Retinal fundus photograph. 848 x 848 pixels. Nonmydriatic fundus photograph: 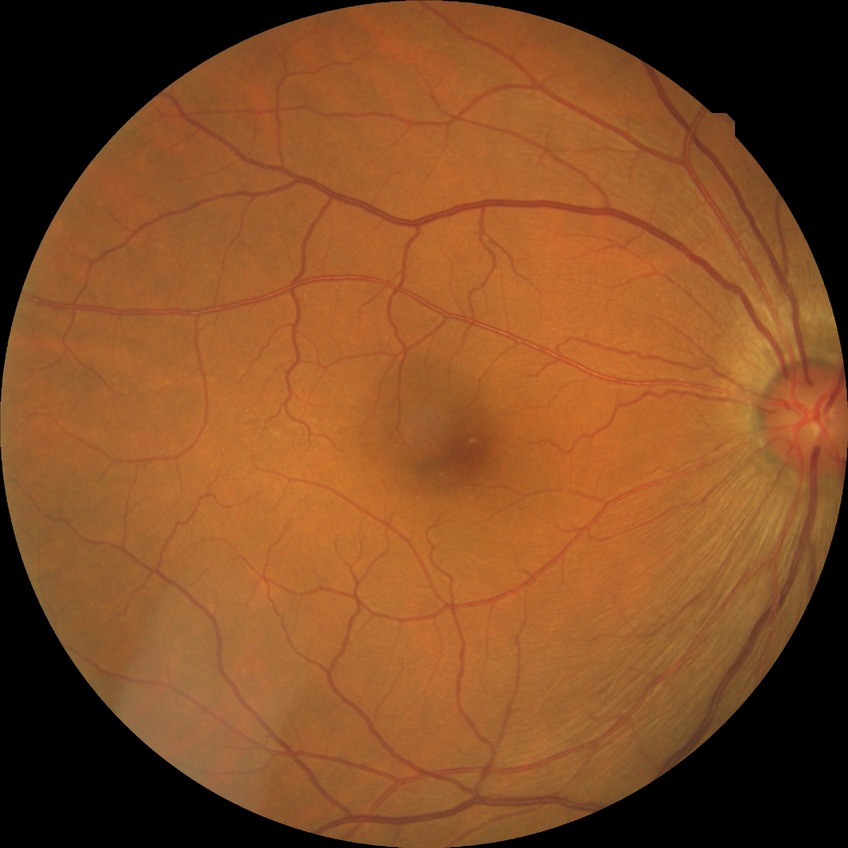
diabetic retinopathy (DR) = NDR (no diabetic retinopathy).